Wide-field contact fundus photograph of an infant:
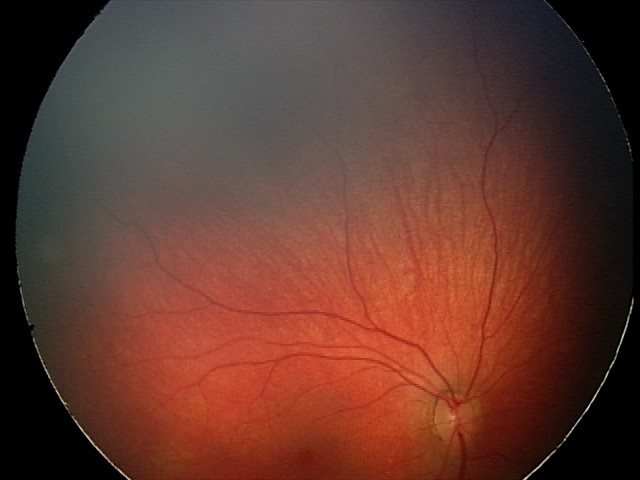

Series diagnosed as retinal hemorrhages.